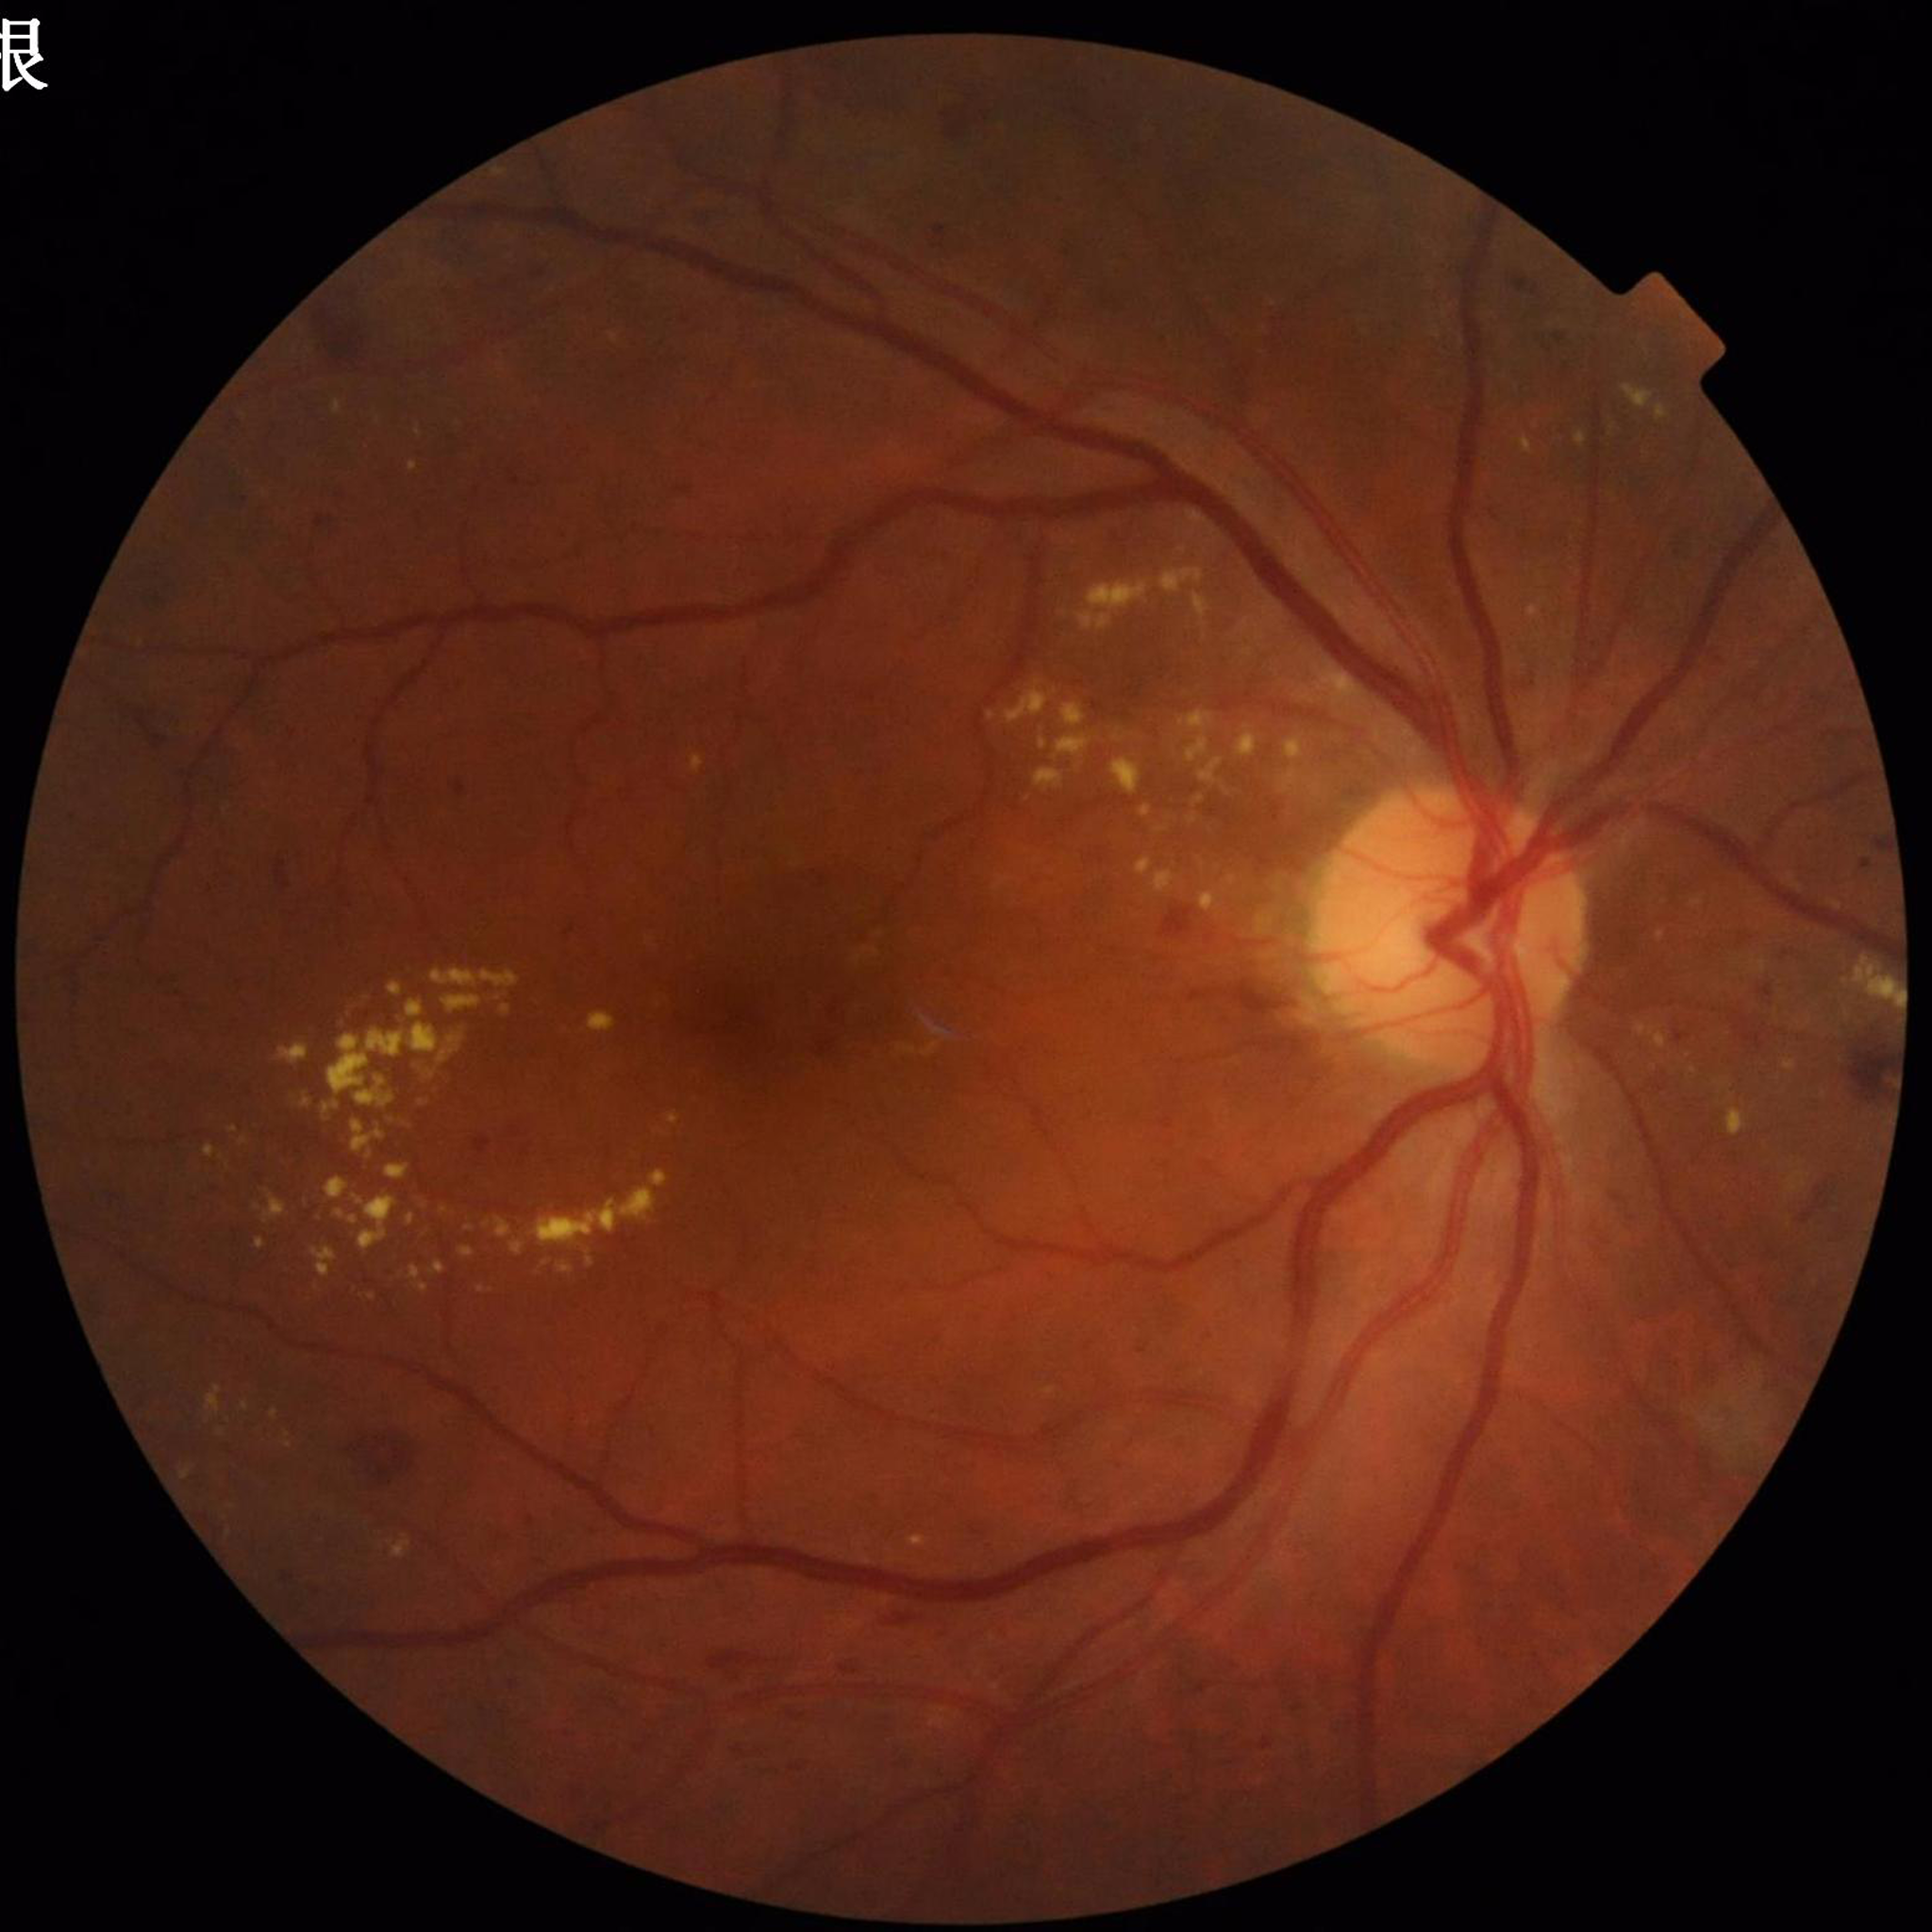
Condition: diabetic retinopathy (DR).